316 x 316 pixels; 35° field of view before cropping; optic nerve head photograph — 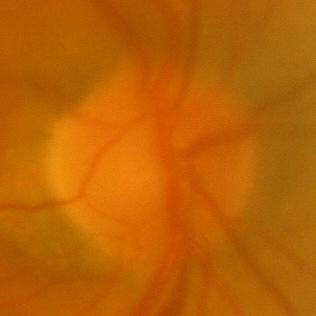 Consistent with no glaucomatous changes.